Retinal fundus photograph.
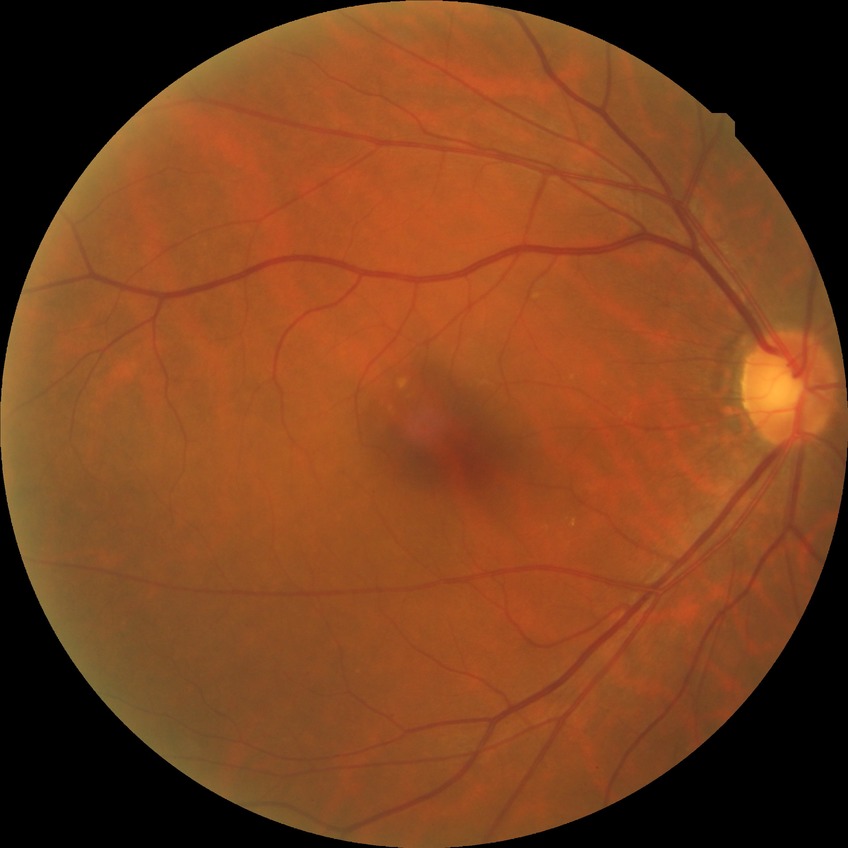

Modified Davis grading is no diabetic retinopathy.